640x480 · wide-field contact fundus photograph of an infant · 130° field of view (Clarity RetCam 3).
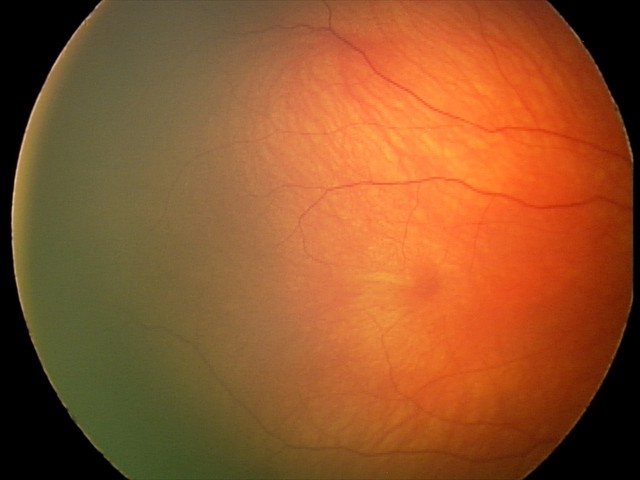

Screening examination consistent with retinal hemorrhages.